Camera: NIDEK AFC-230. 45° field of view
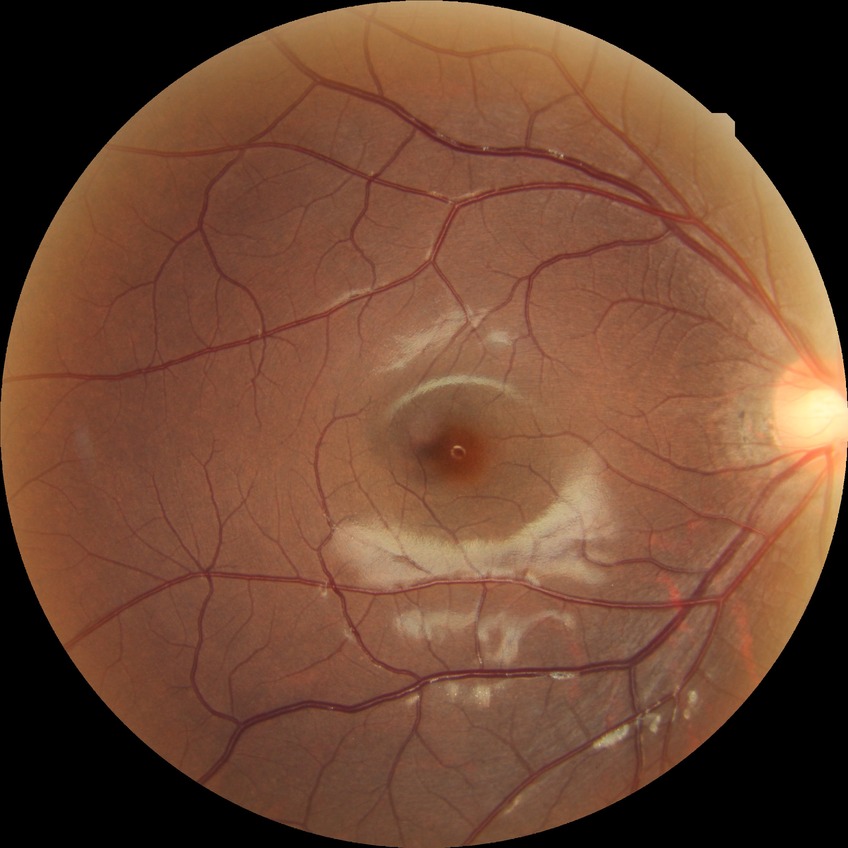

DR impression = no apparent DR
Davis DR grade = NDR